Acquired with a Topcon TRC-NW400; 2212x1661; color fundus photograph; patient age: 62 years; centered on the optic disc: 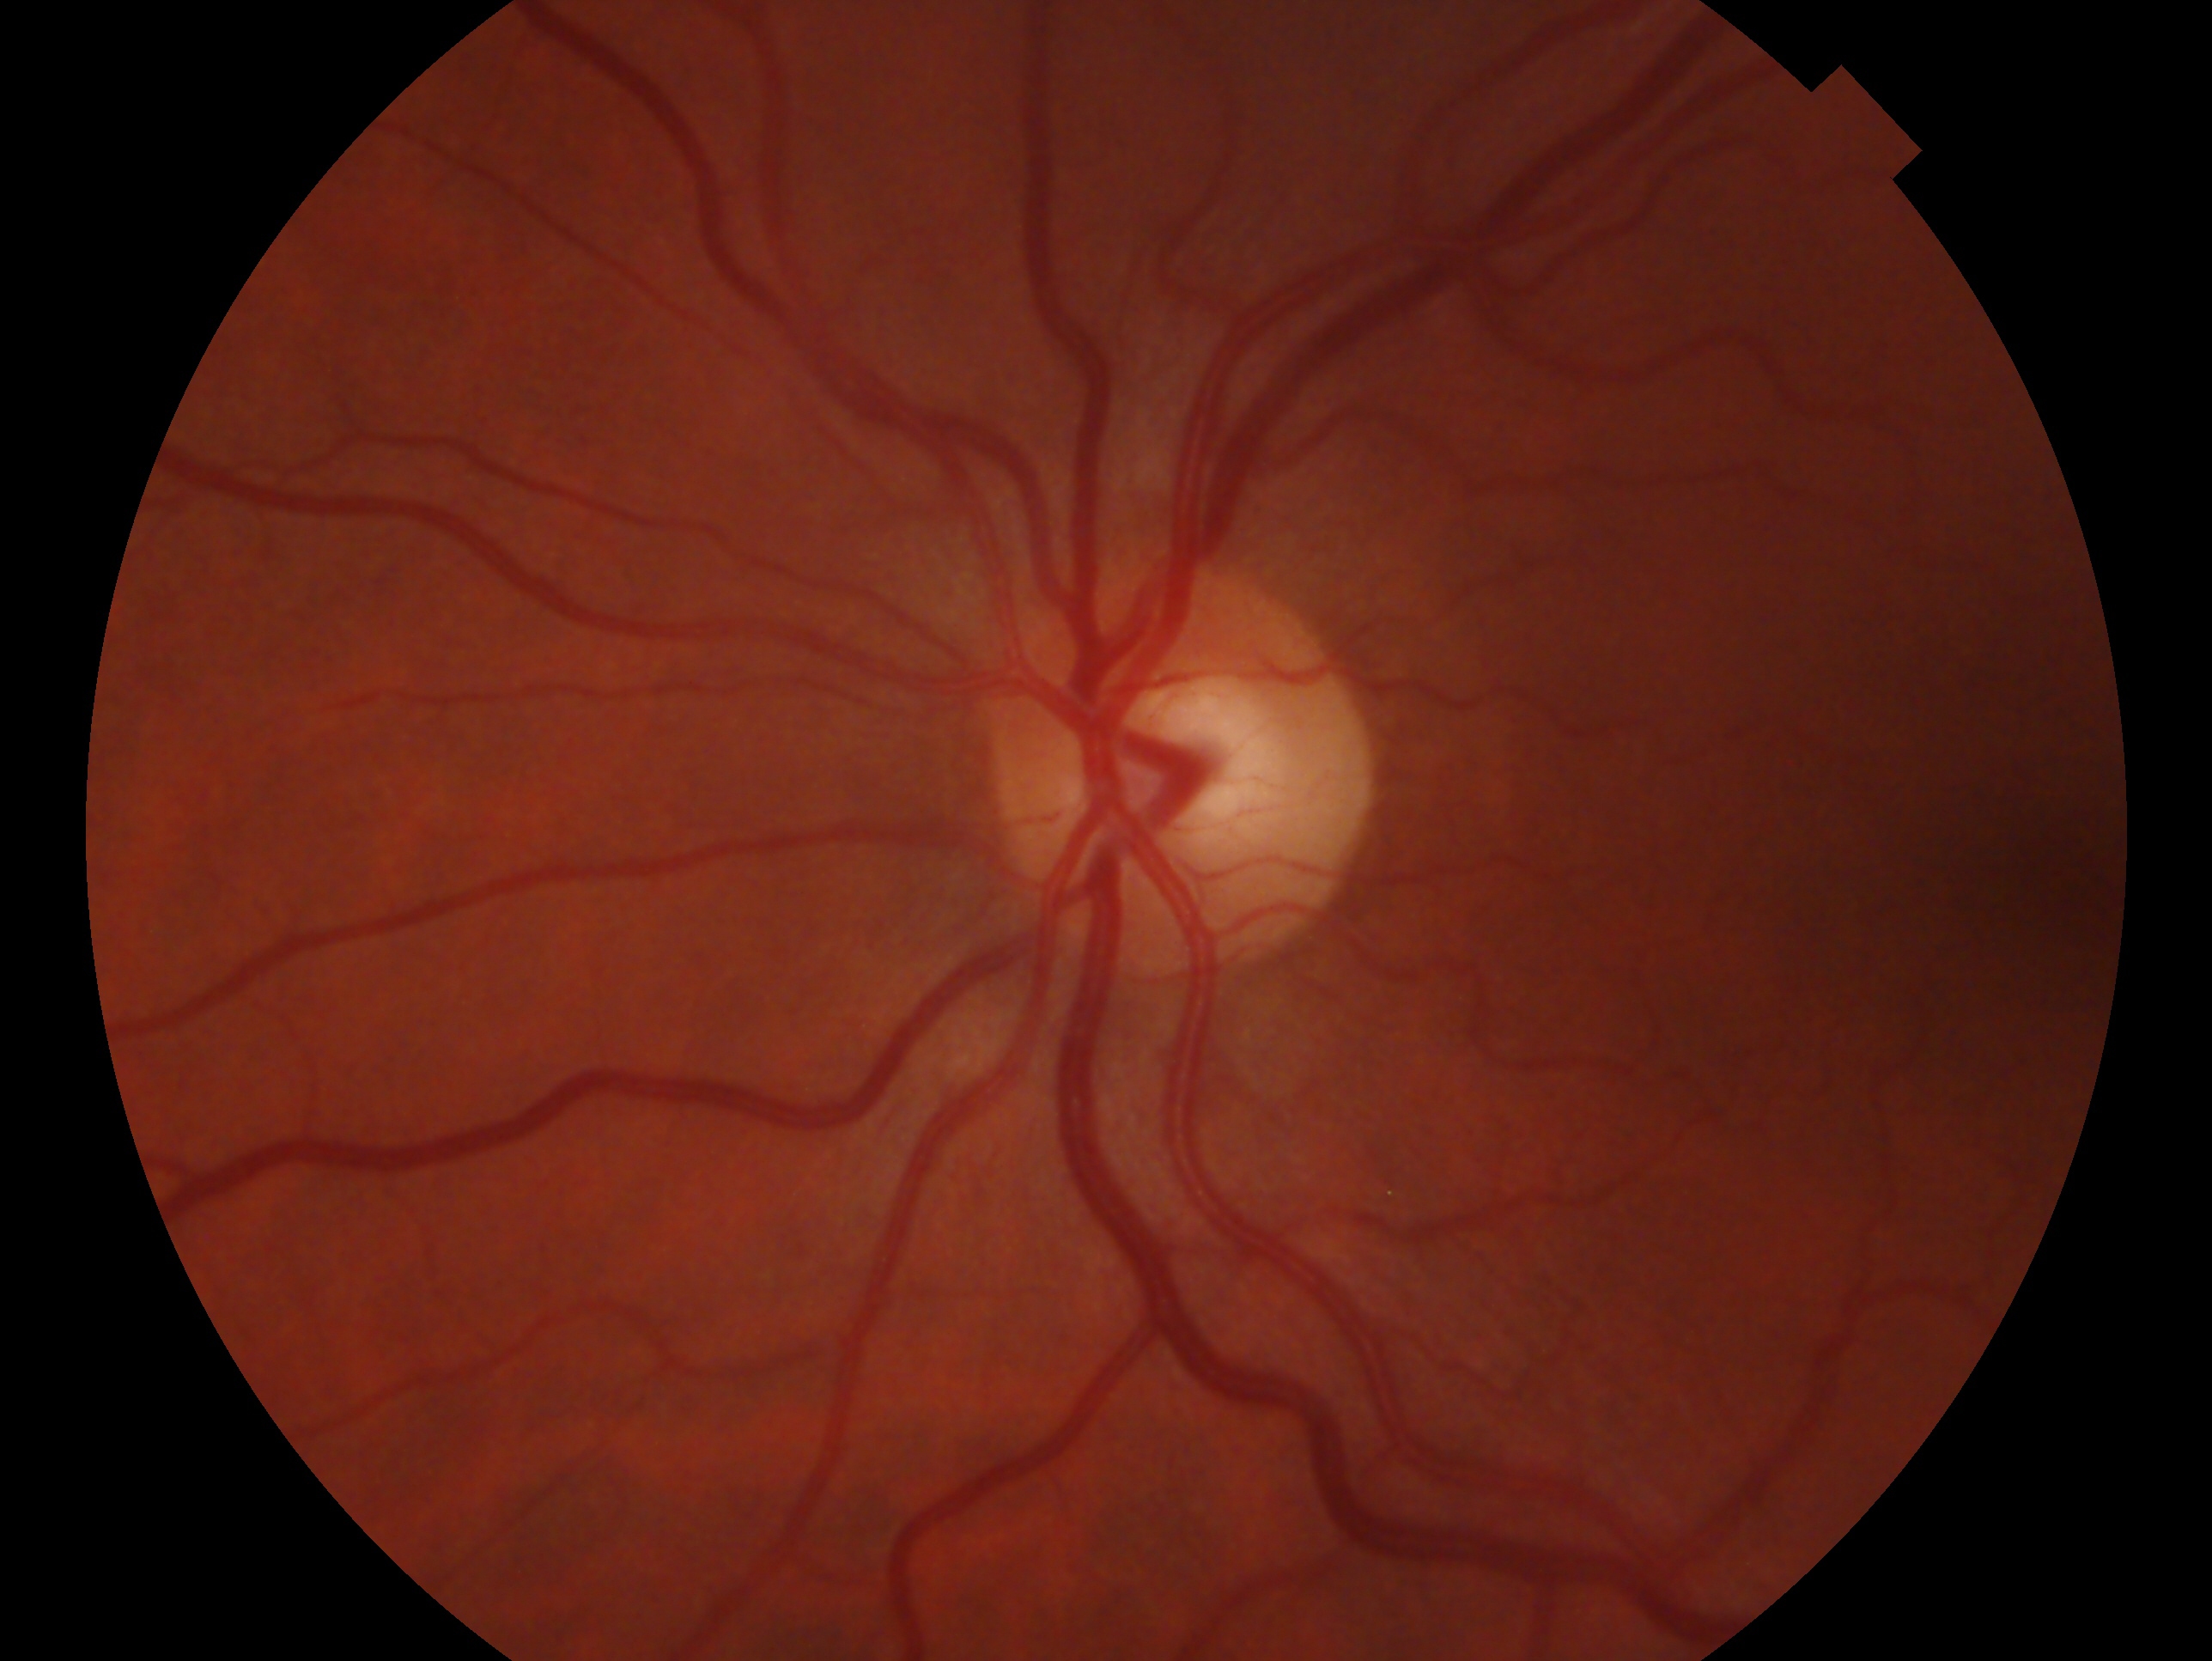

Imaged eye: left. Glaucoma assessment: no signs of glaucoma.